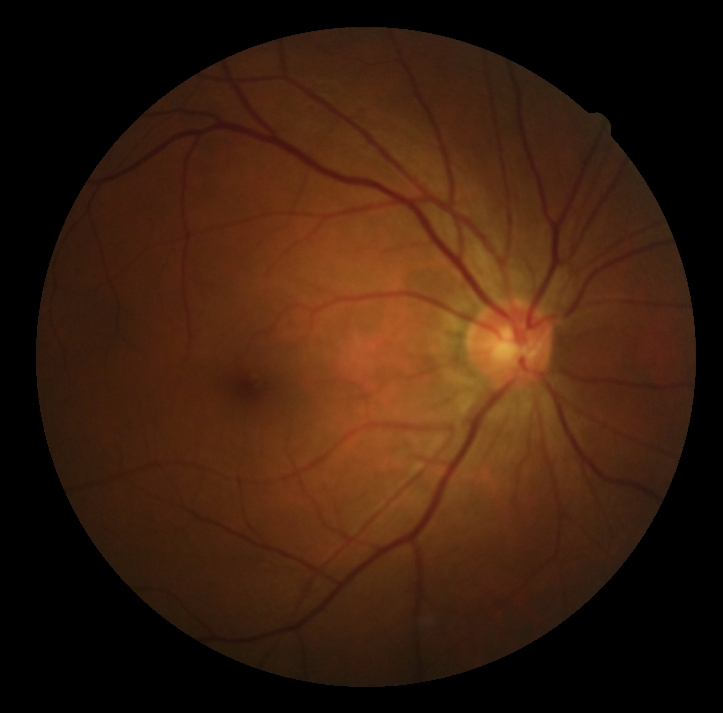

DR impression: no apparent DR, DR stage: grade 0 (no apparent retinopathy) — no visible signs of diabetic retinopathy.